Color fundus image:
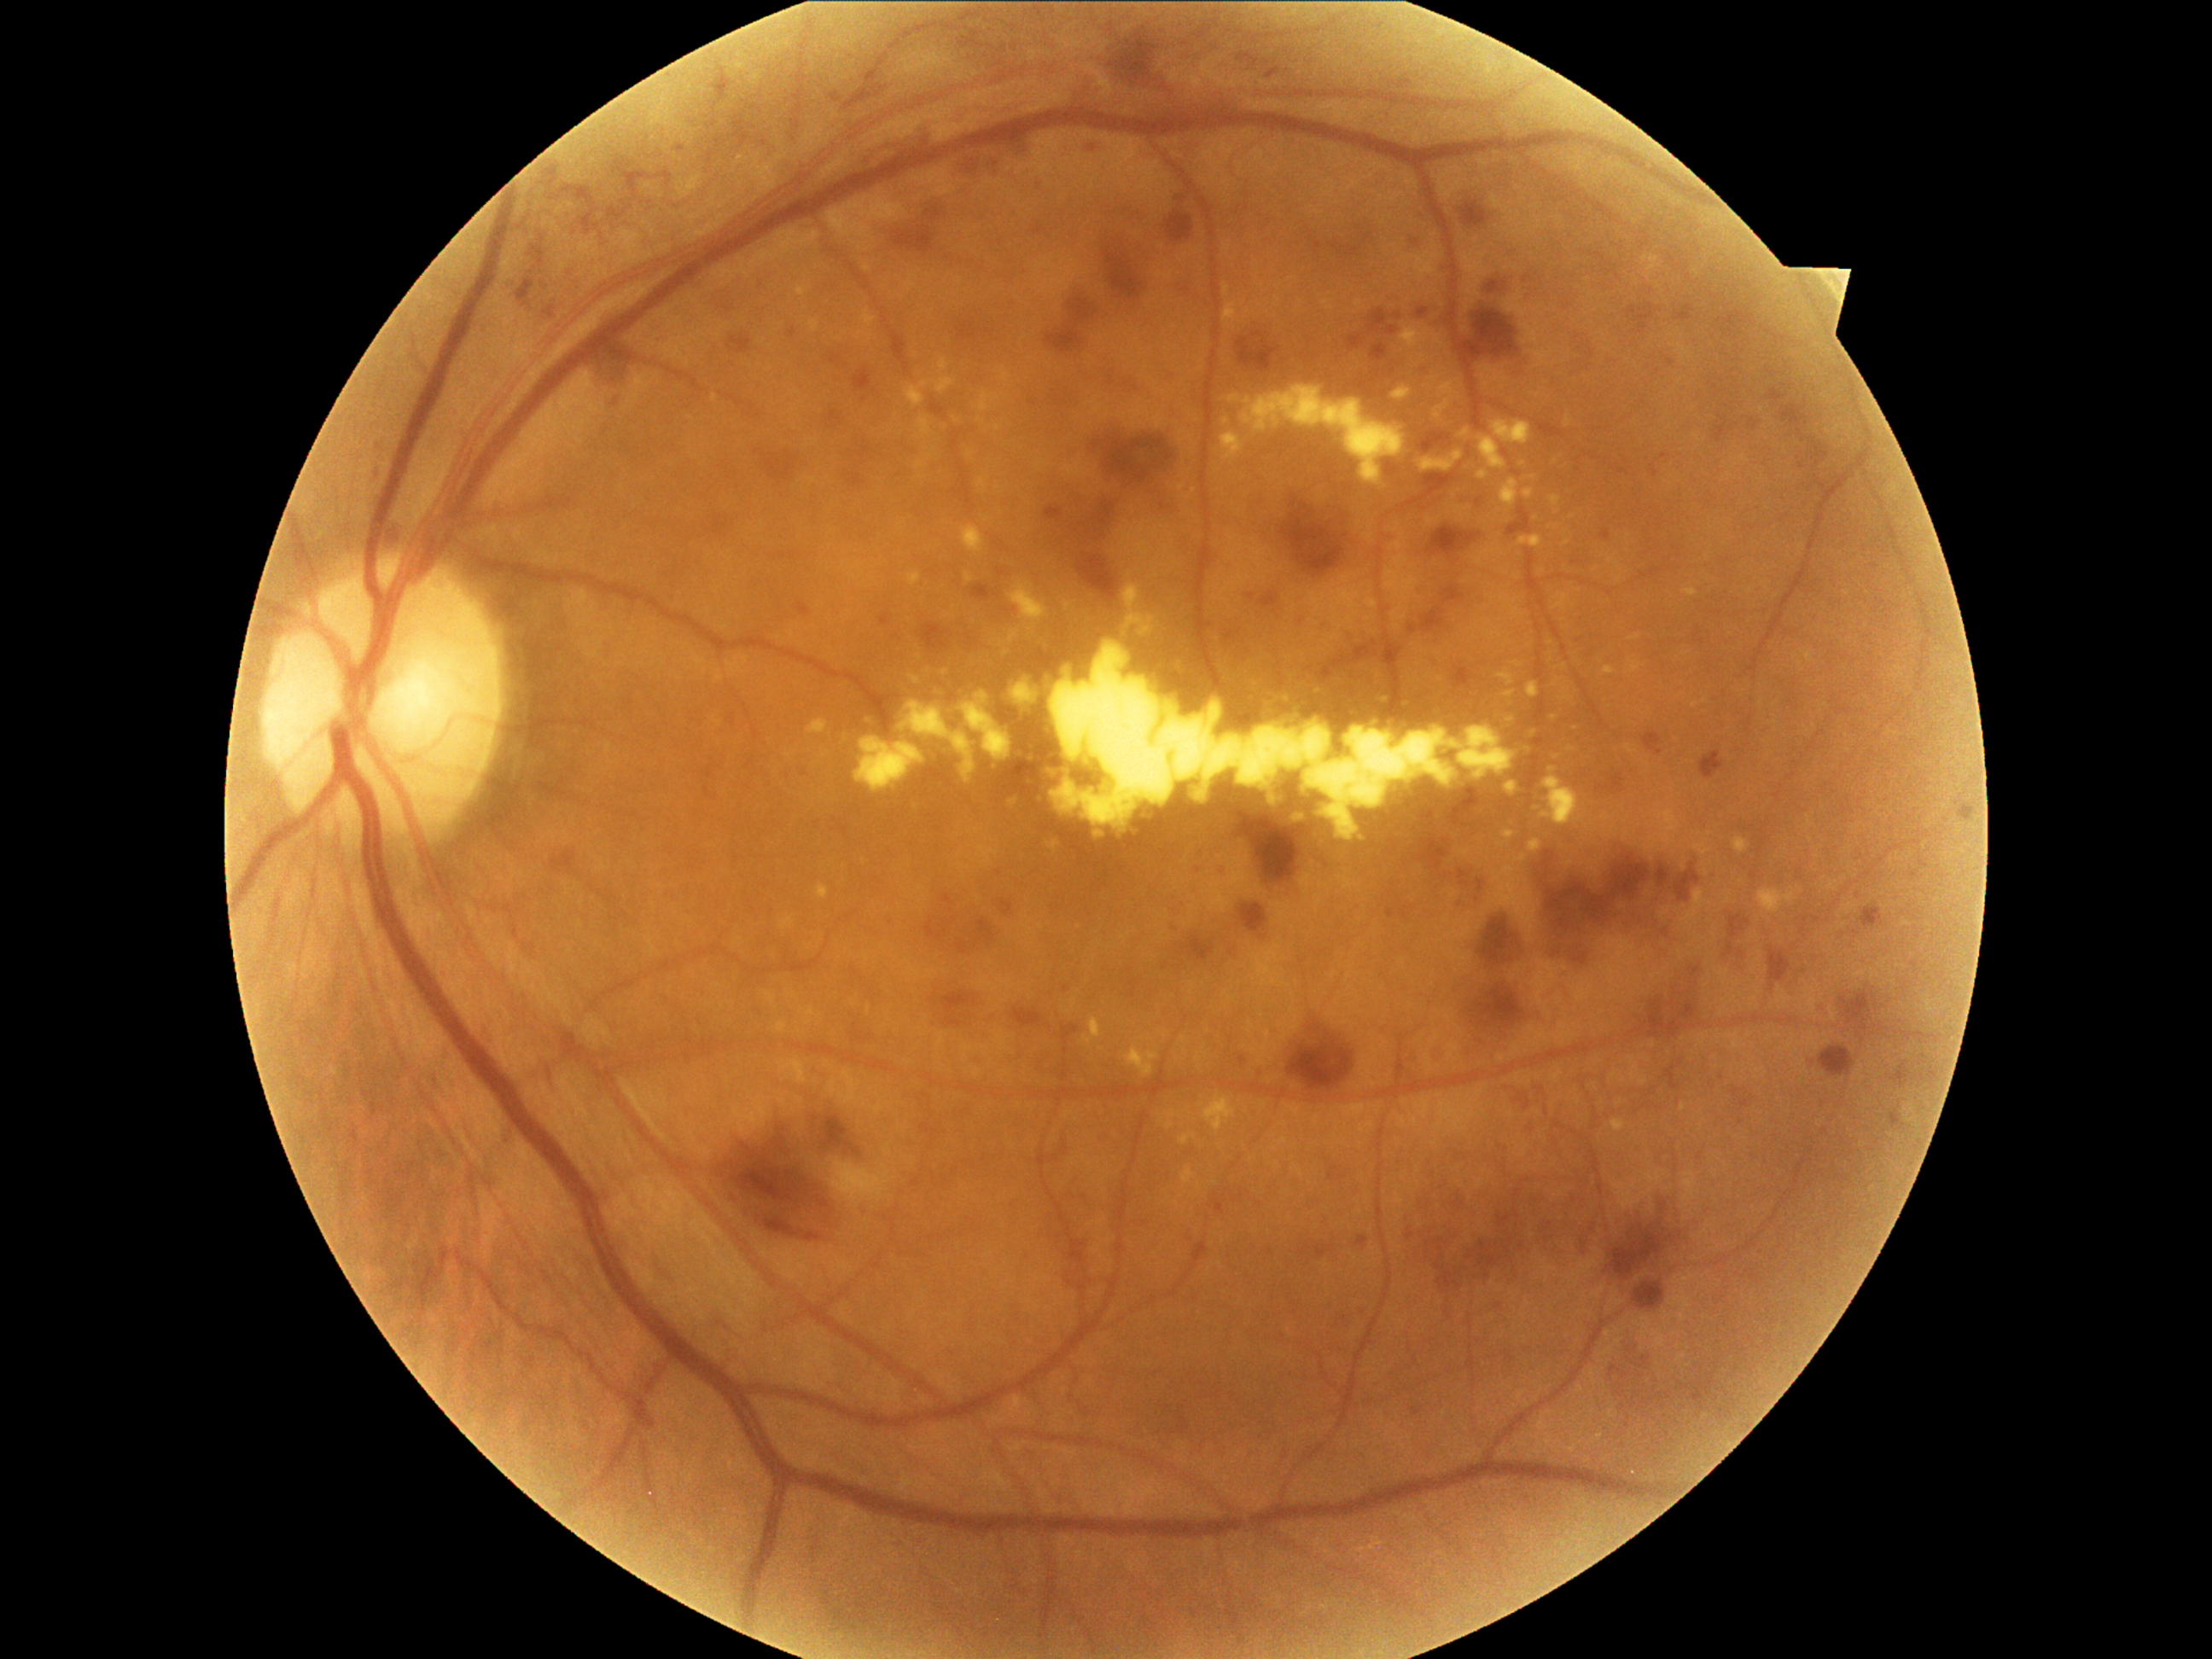
{"partial":true,"dr_grade":3,"dr_grade_name":"severe NPDR","lesions":{"ex":[[854,736,926,795],[960,448,982,467],[1122,615,1158,634],[1733,839,1749,854],[1518,535,1544,547],[1049,644,1518,844],[1605,667,1617,675],[1479,436,1508,472],[975,479,991,491],[1460,429,1472,441],[1126,1045,1160,1078],[1525,475,1537,480],[817,883,830,899]],"ex_small":[[1566,542]],"se":null,"ma":[[1651,469,1658,479],[677,146,685,153],[1732,1088,1754,1110],[1238,1056,1247,1066],[1177,197,1187,202],[1184,291,1192,296],[1412,1407,1421,1416]],"ma_small":[[995,163],[921,637],[1093,148]],"he":[[1182,139,1202,170],[1010,607,1018,615],[1479,919,1518,967],[967,160,982,175],[1242,817,1295,887],[1511,358,1525,371],[1539,842,1701,969],[1607,774,1626,796],[1858,902,1885,933],[1629,998,1697,1042],[878,615,890,627],[844,474,864,489],[1819,1045,1860,1085],[1426,470,1445,489],[1769,946,1793,989],[1458,199,1491,226]],"he_small":[[951,912],[1070,264]]}}